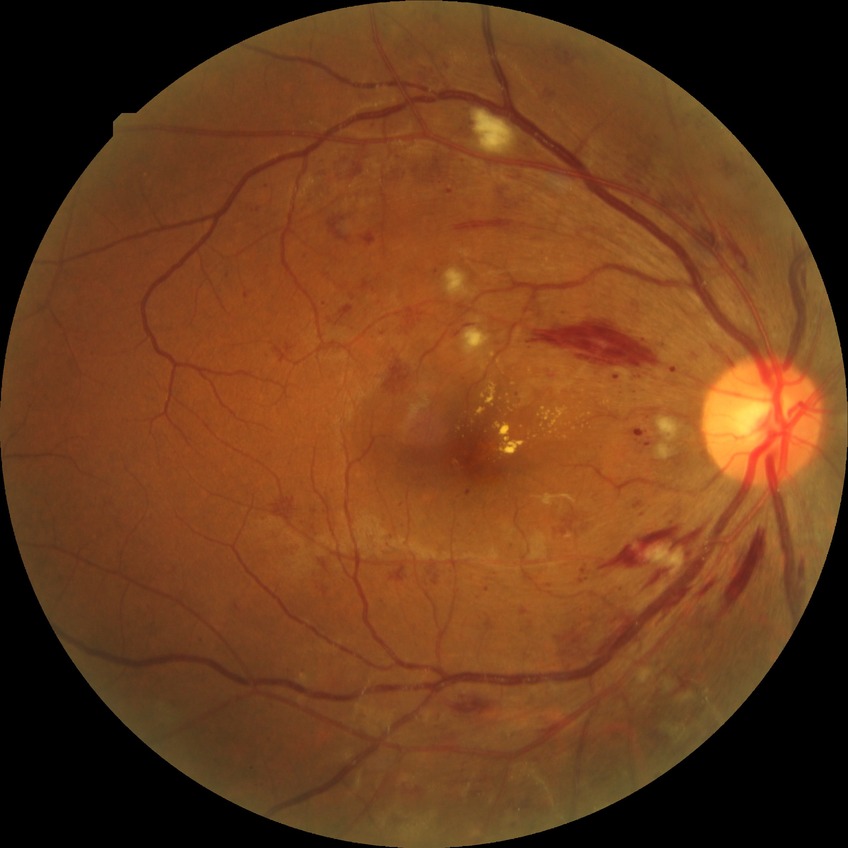
DR class: non-proliferative diabetic retinopathy; modified Davis classification: pre-proliferative diabetic retinopathy.